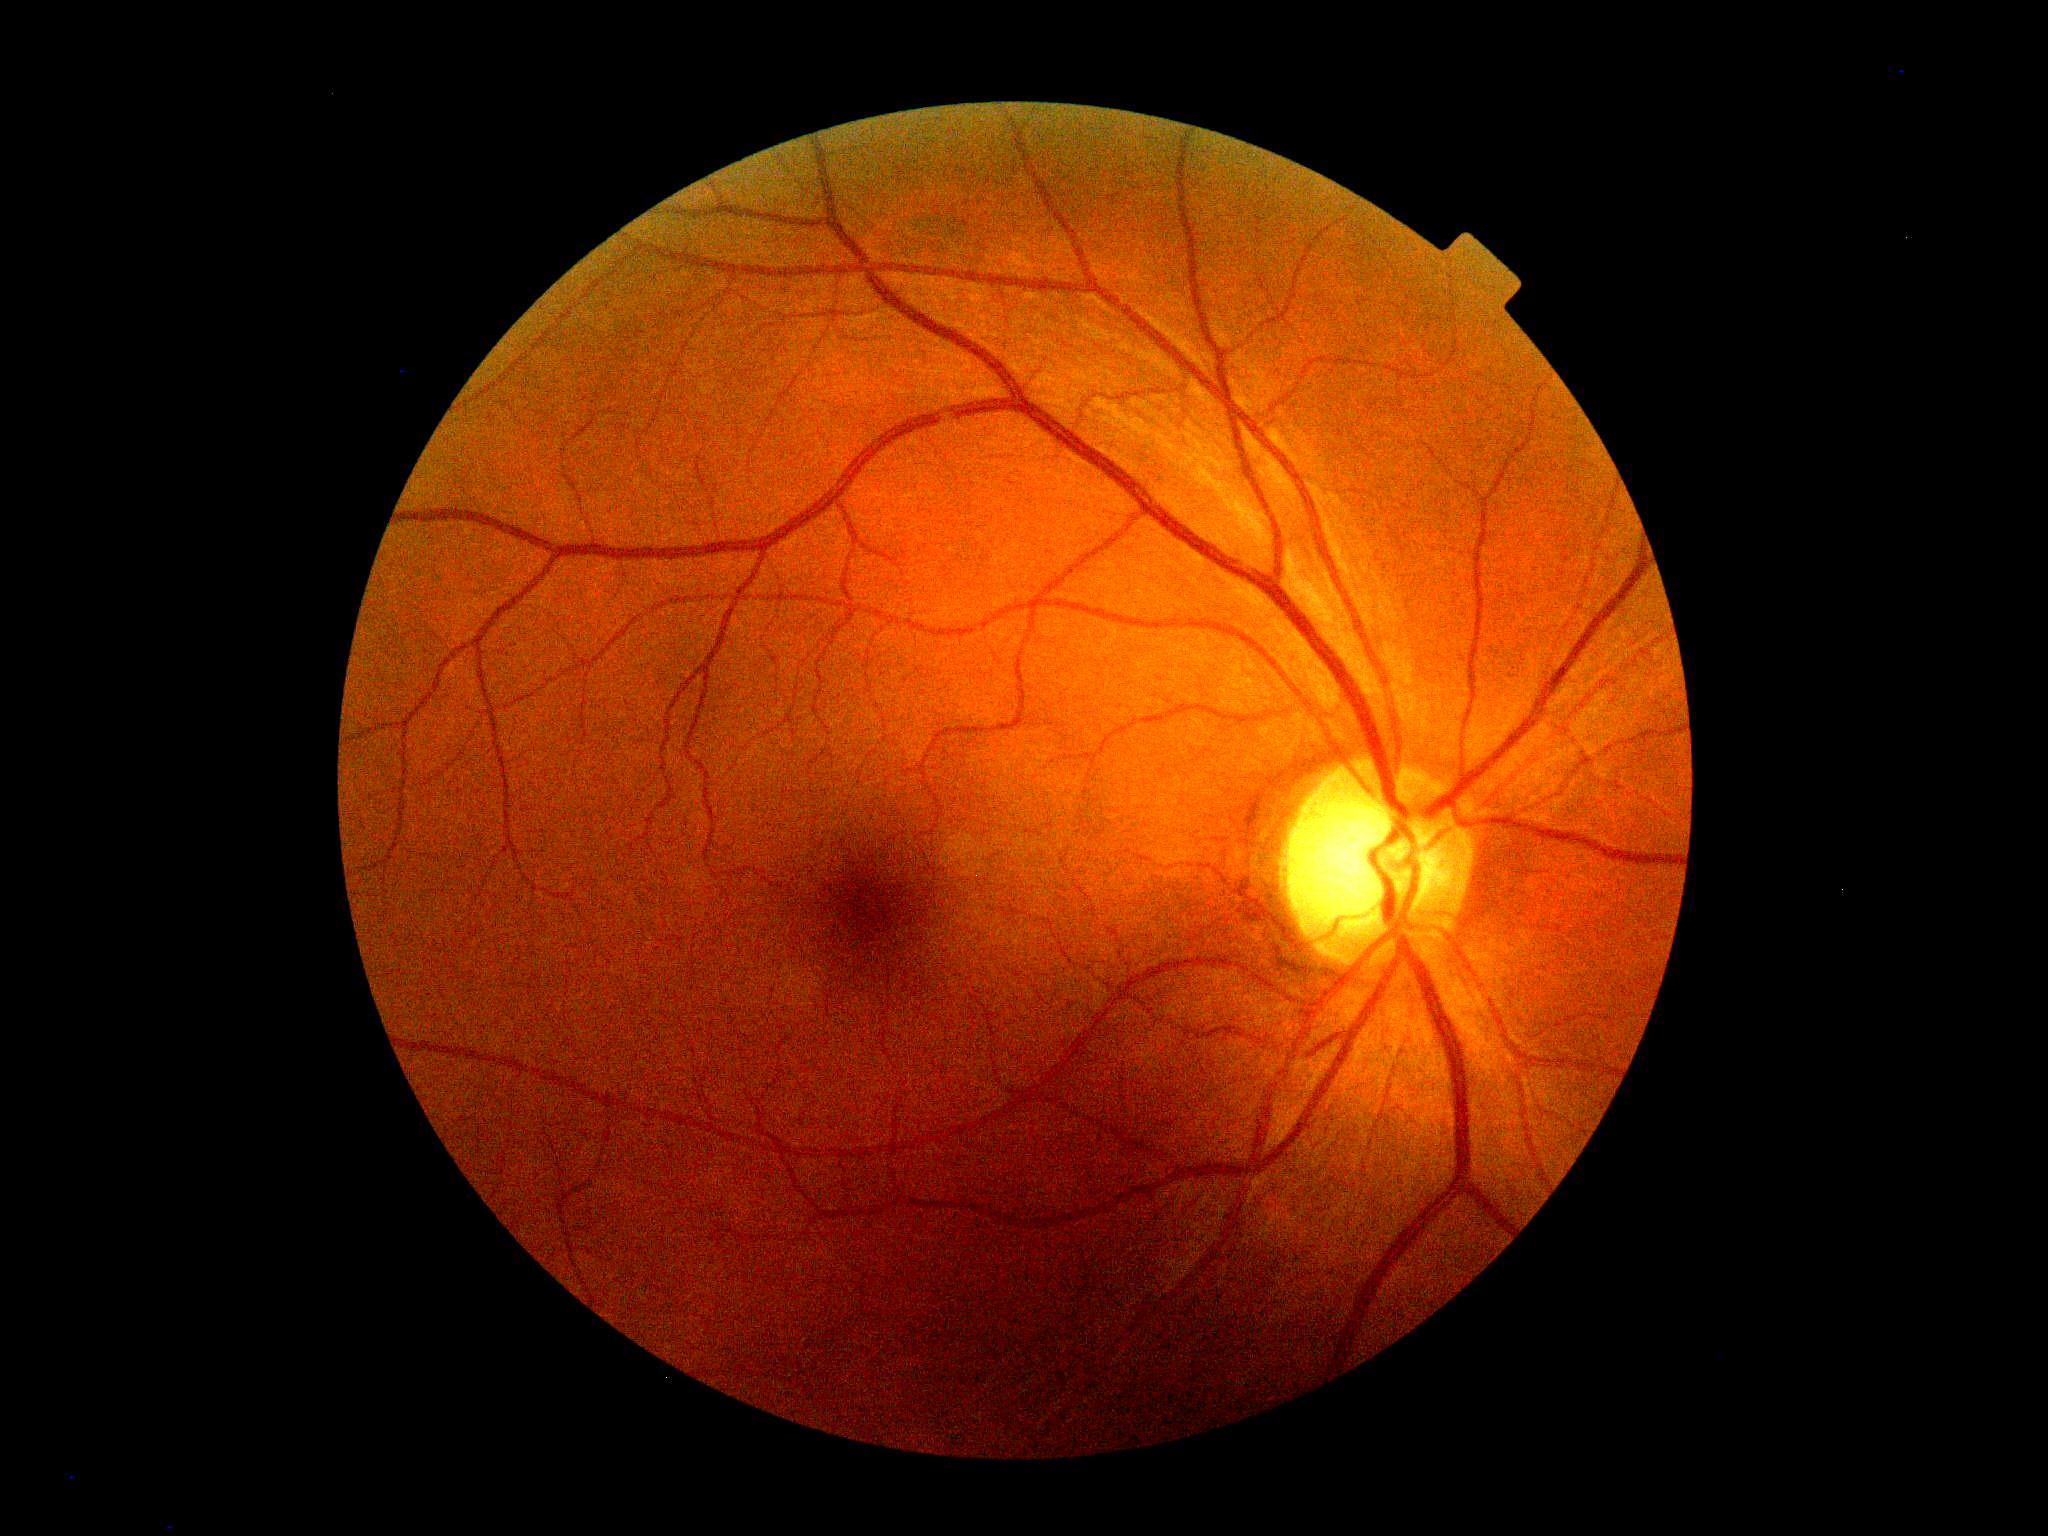

diabetic retinopathy = no apparent retinopathy (grade 0) — no visible signs of diabetic retinopathy.